848 x 848 pixels, fundus photo: 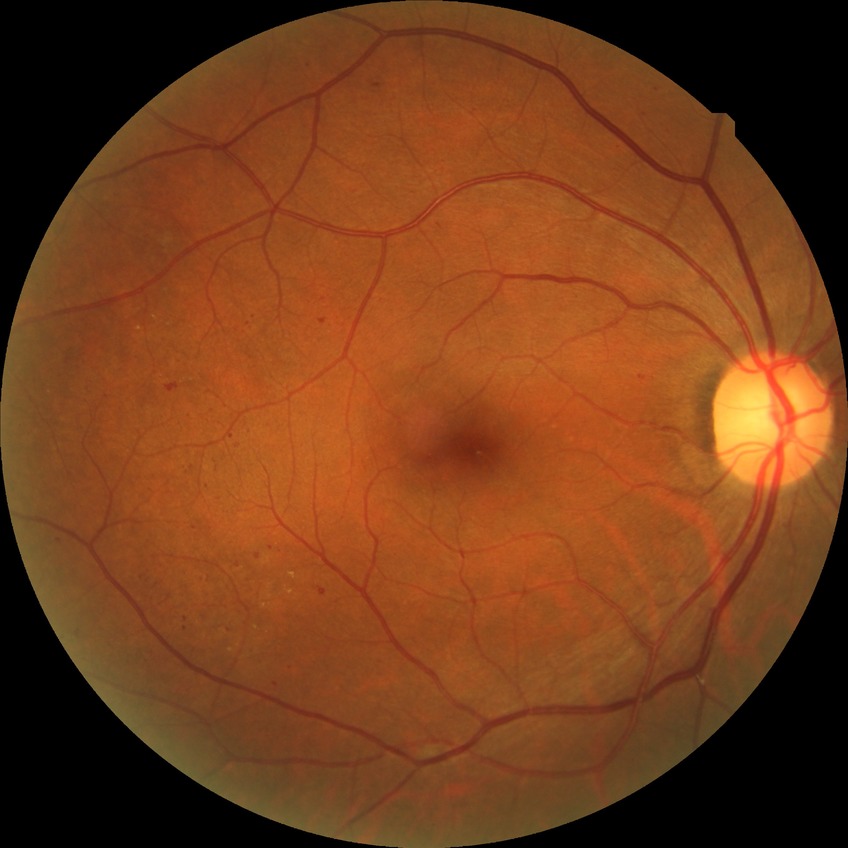
Findings:
* diabetic retinopathy (DR): simple diabetic retinopathy (SDR)